Posterior pole photograph; nonmydriatic; 848x848px.
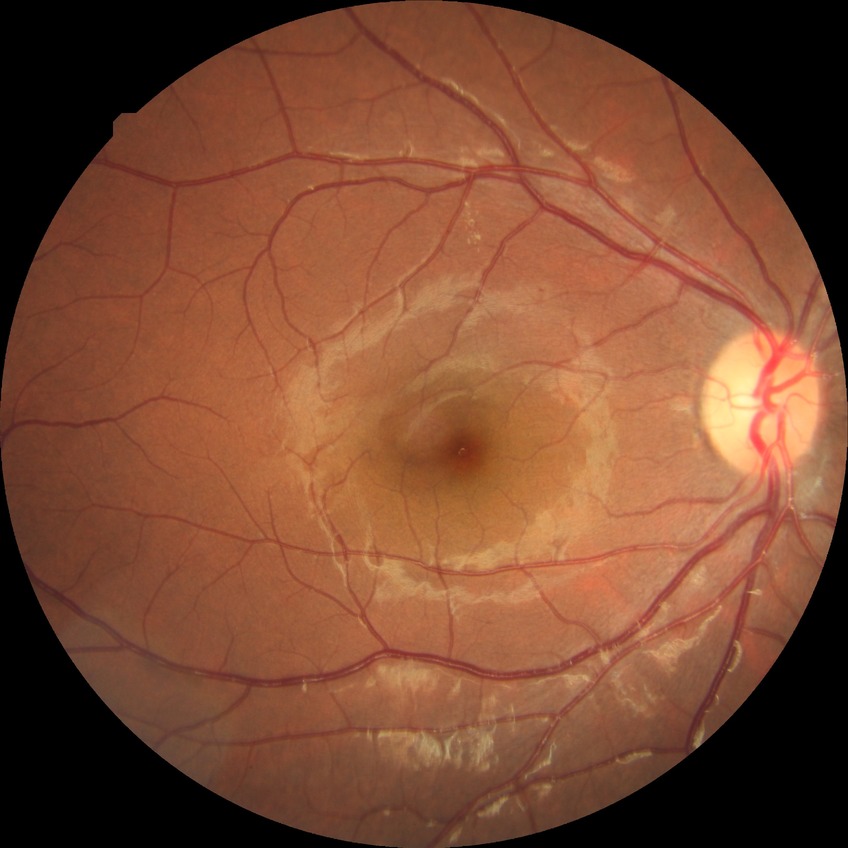

diabetic retinopathy (DR)=SDR (simple diabetic retinopathy).